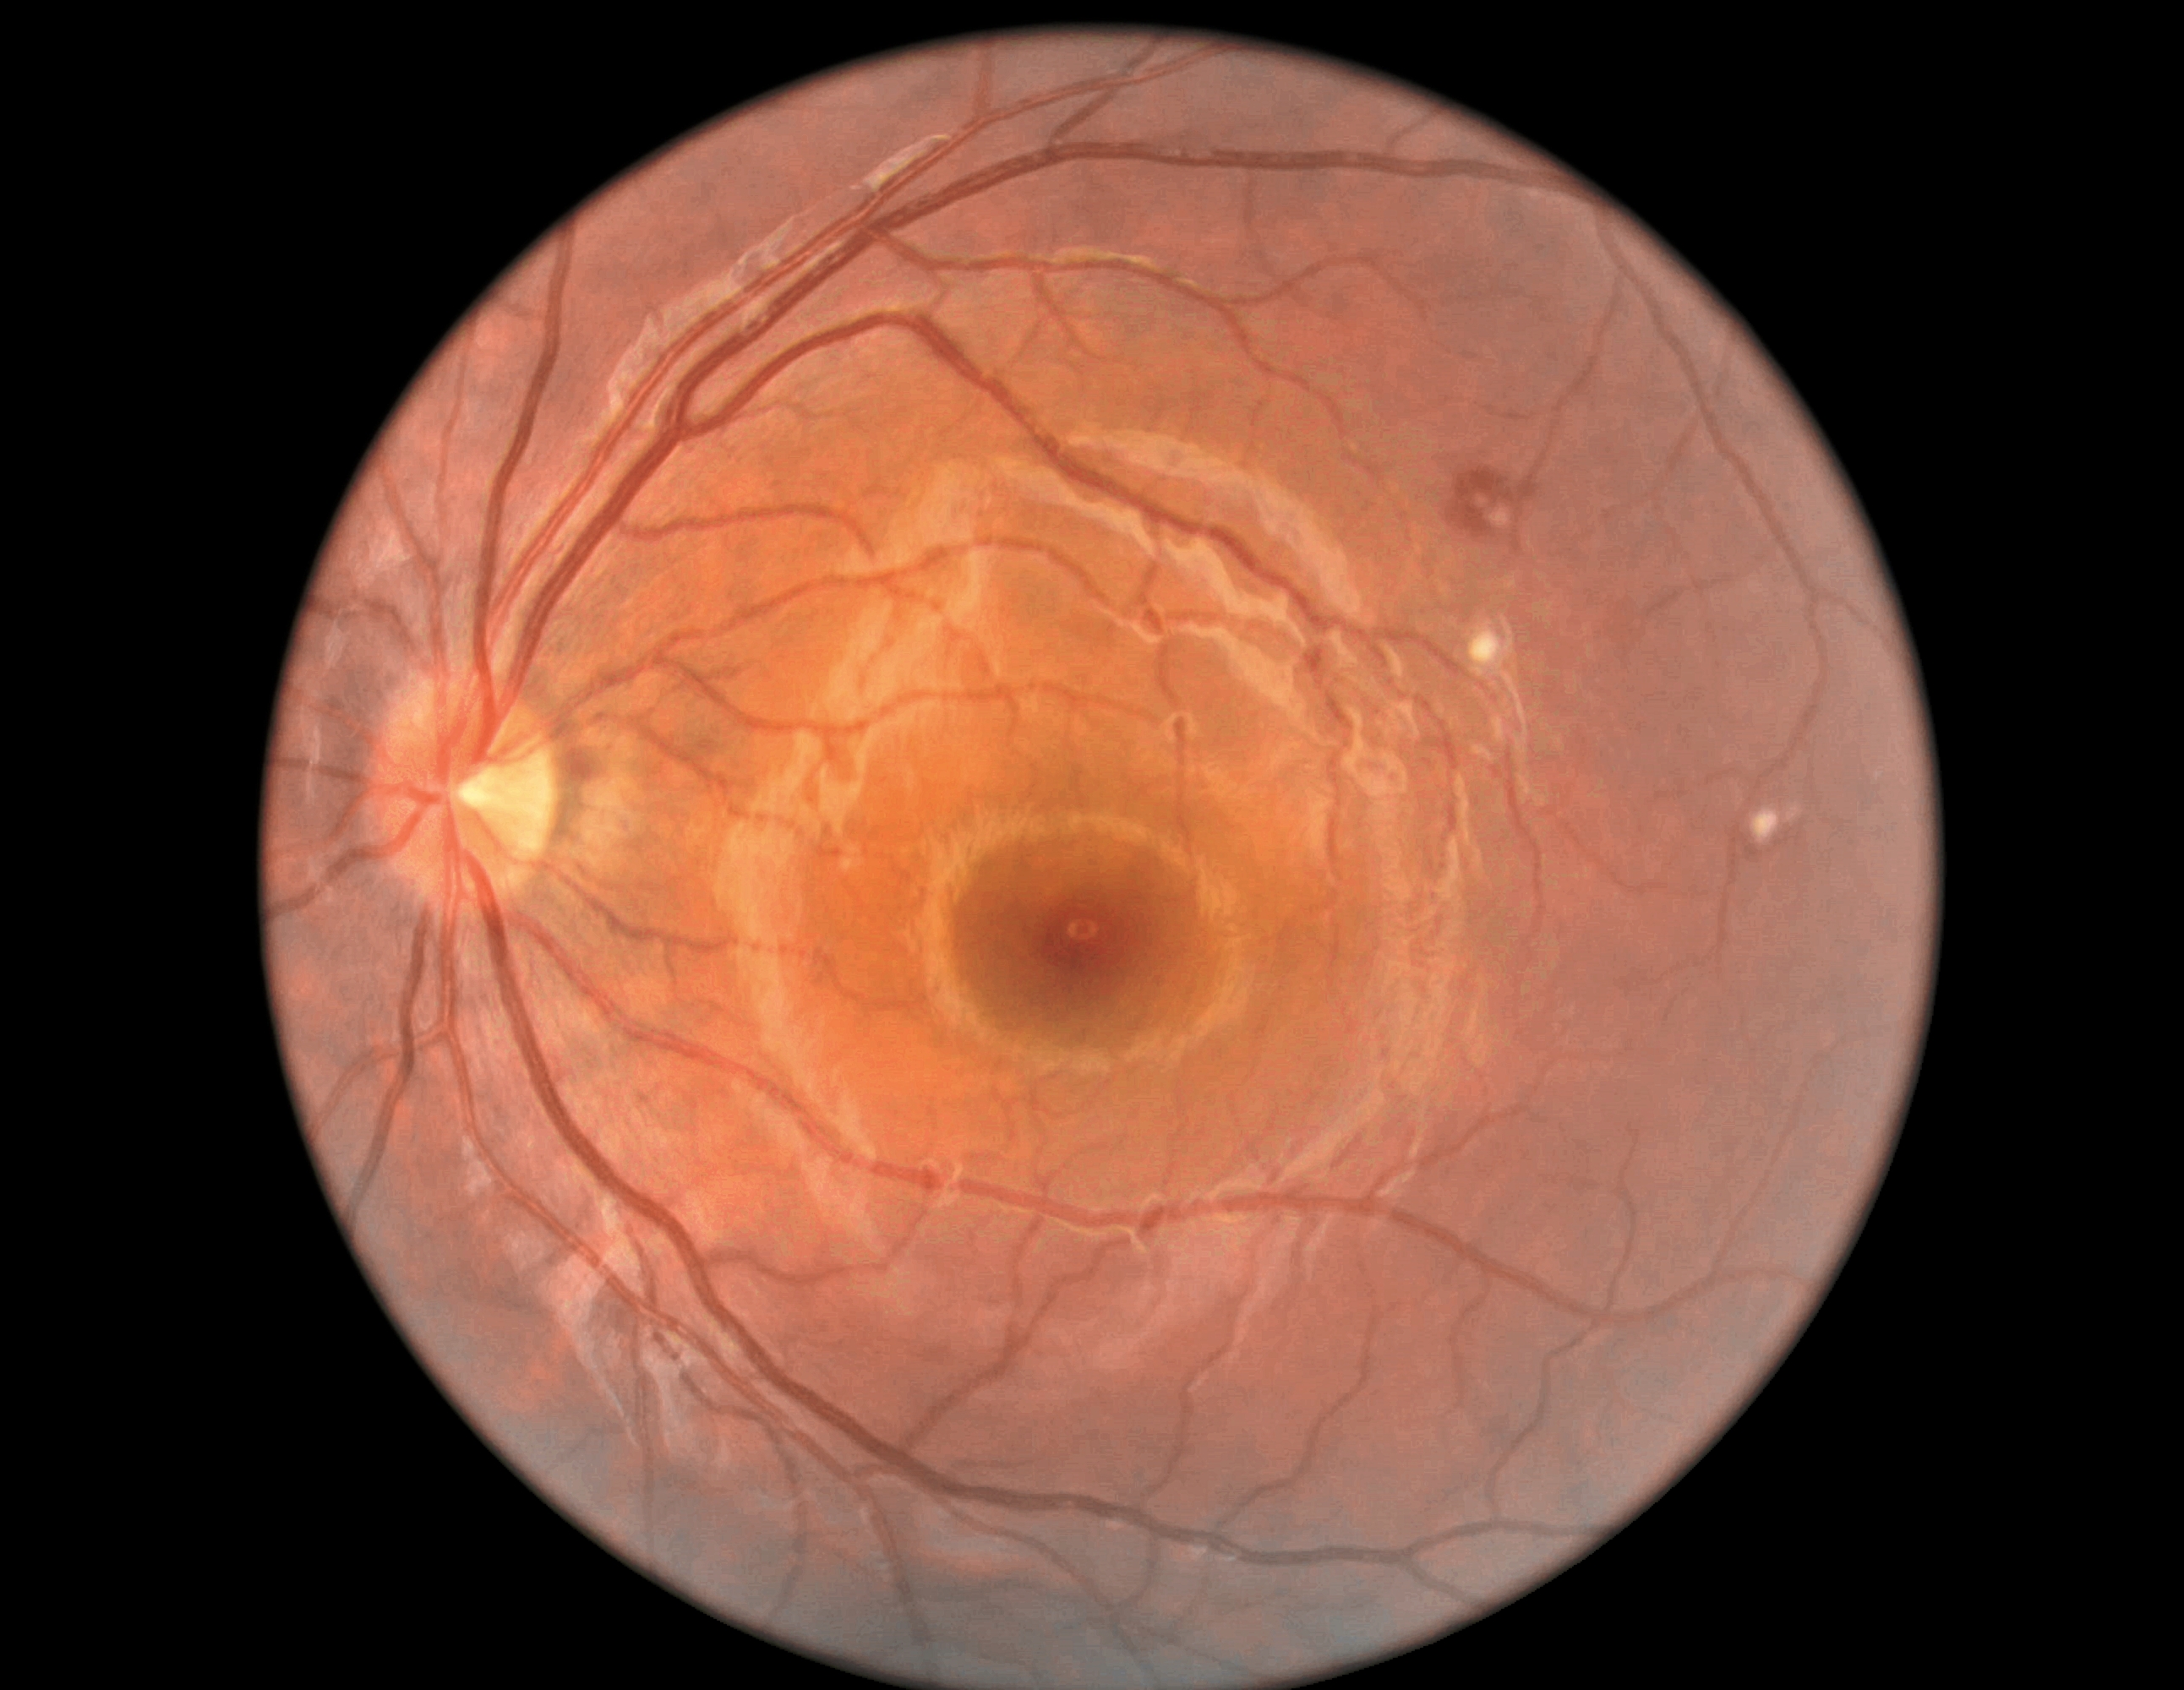

DR class: non-proliferative diabetic retinopathy. DR stage: grade 2 (moderate NPDR) — more than just microaneurysms but less than severe NPDR.